Centered on the macula; camera: Topcon TRC-NW8; 1932 by 1932 pixels: 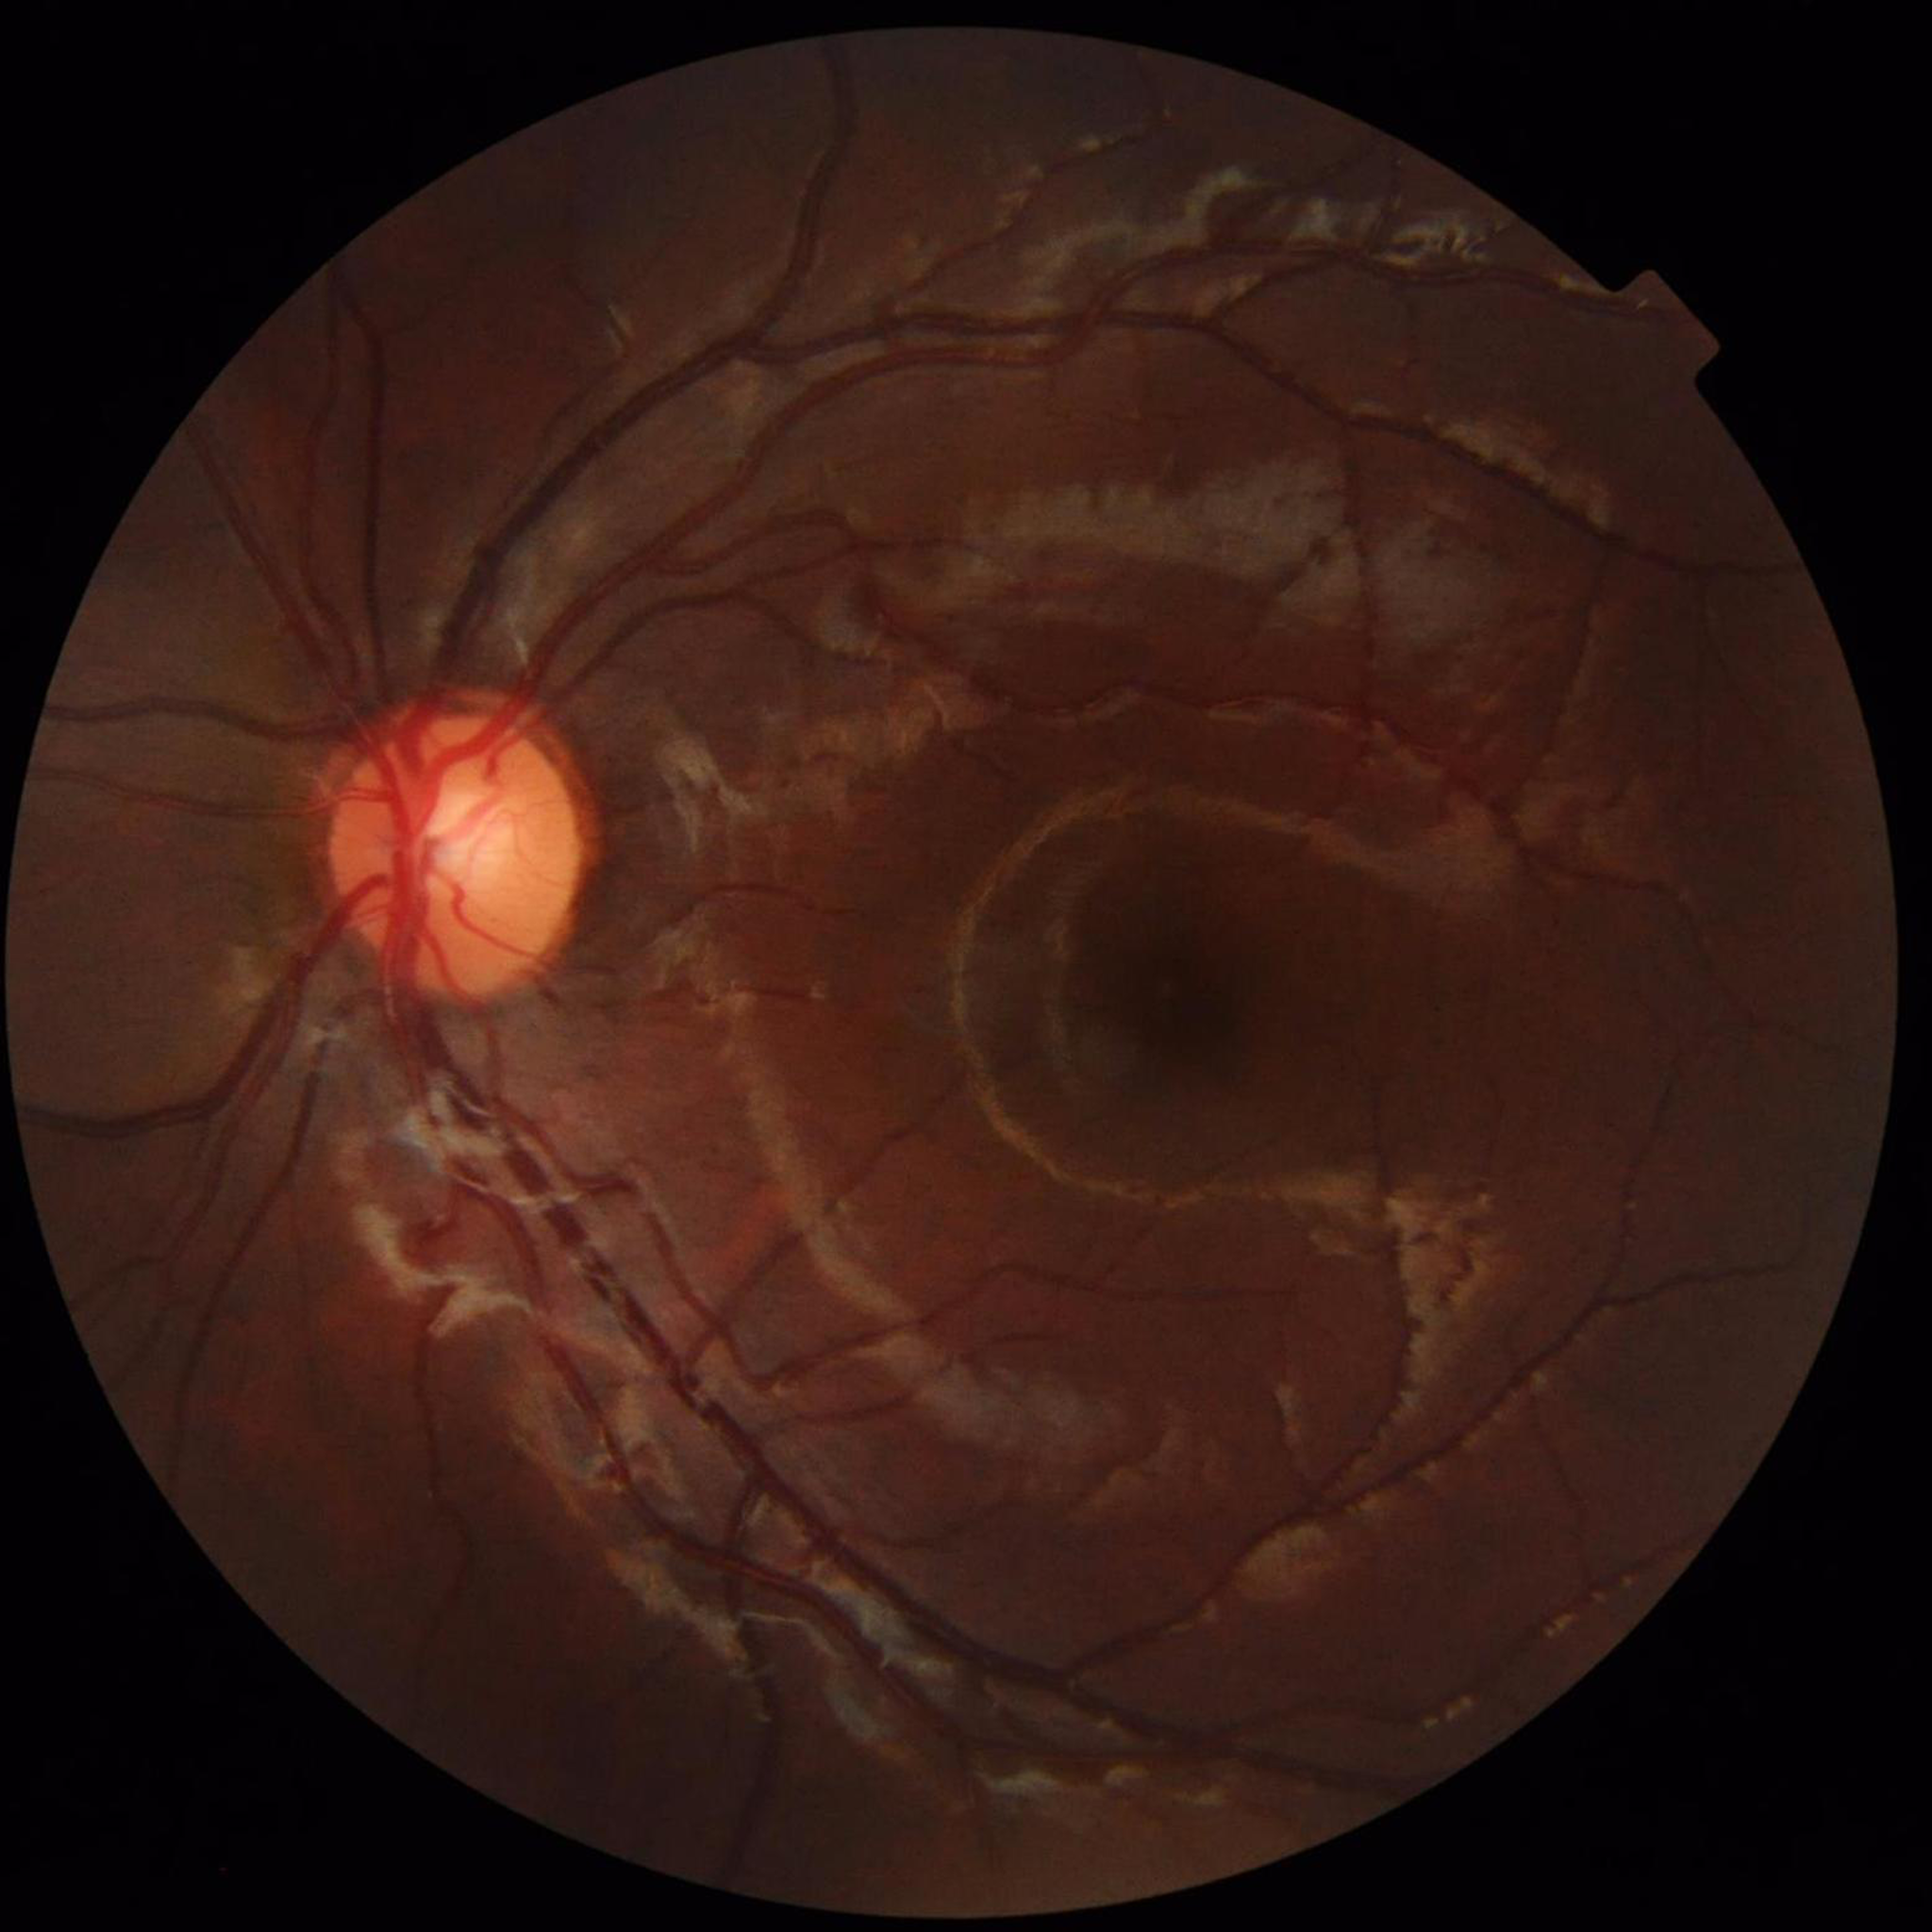 From a control without AMD, diabetic retinopathy, or glaucoma. Quality: suboptimal — illumination/color distortion.